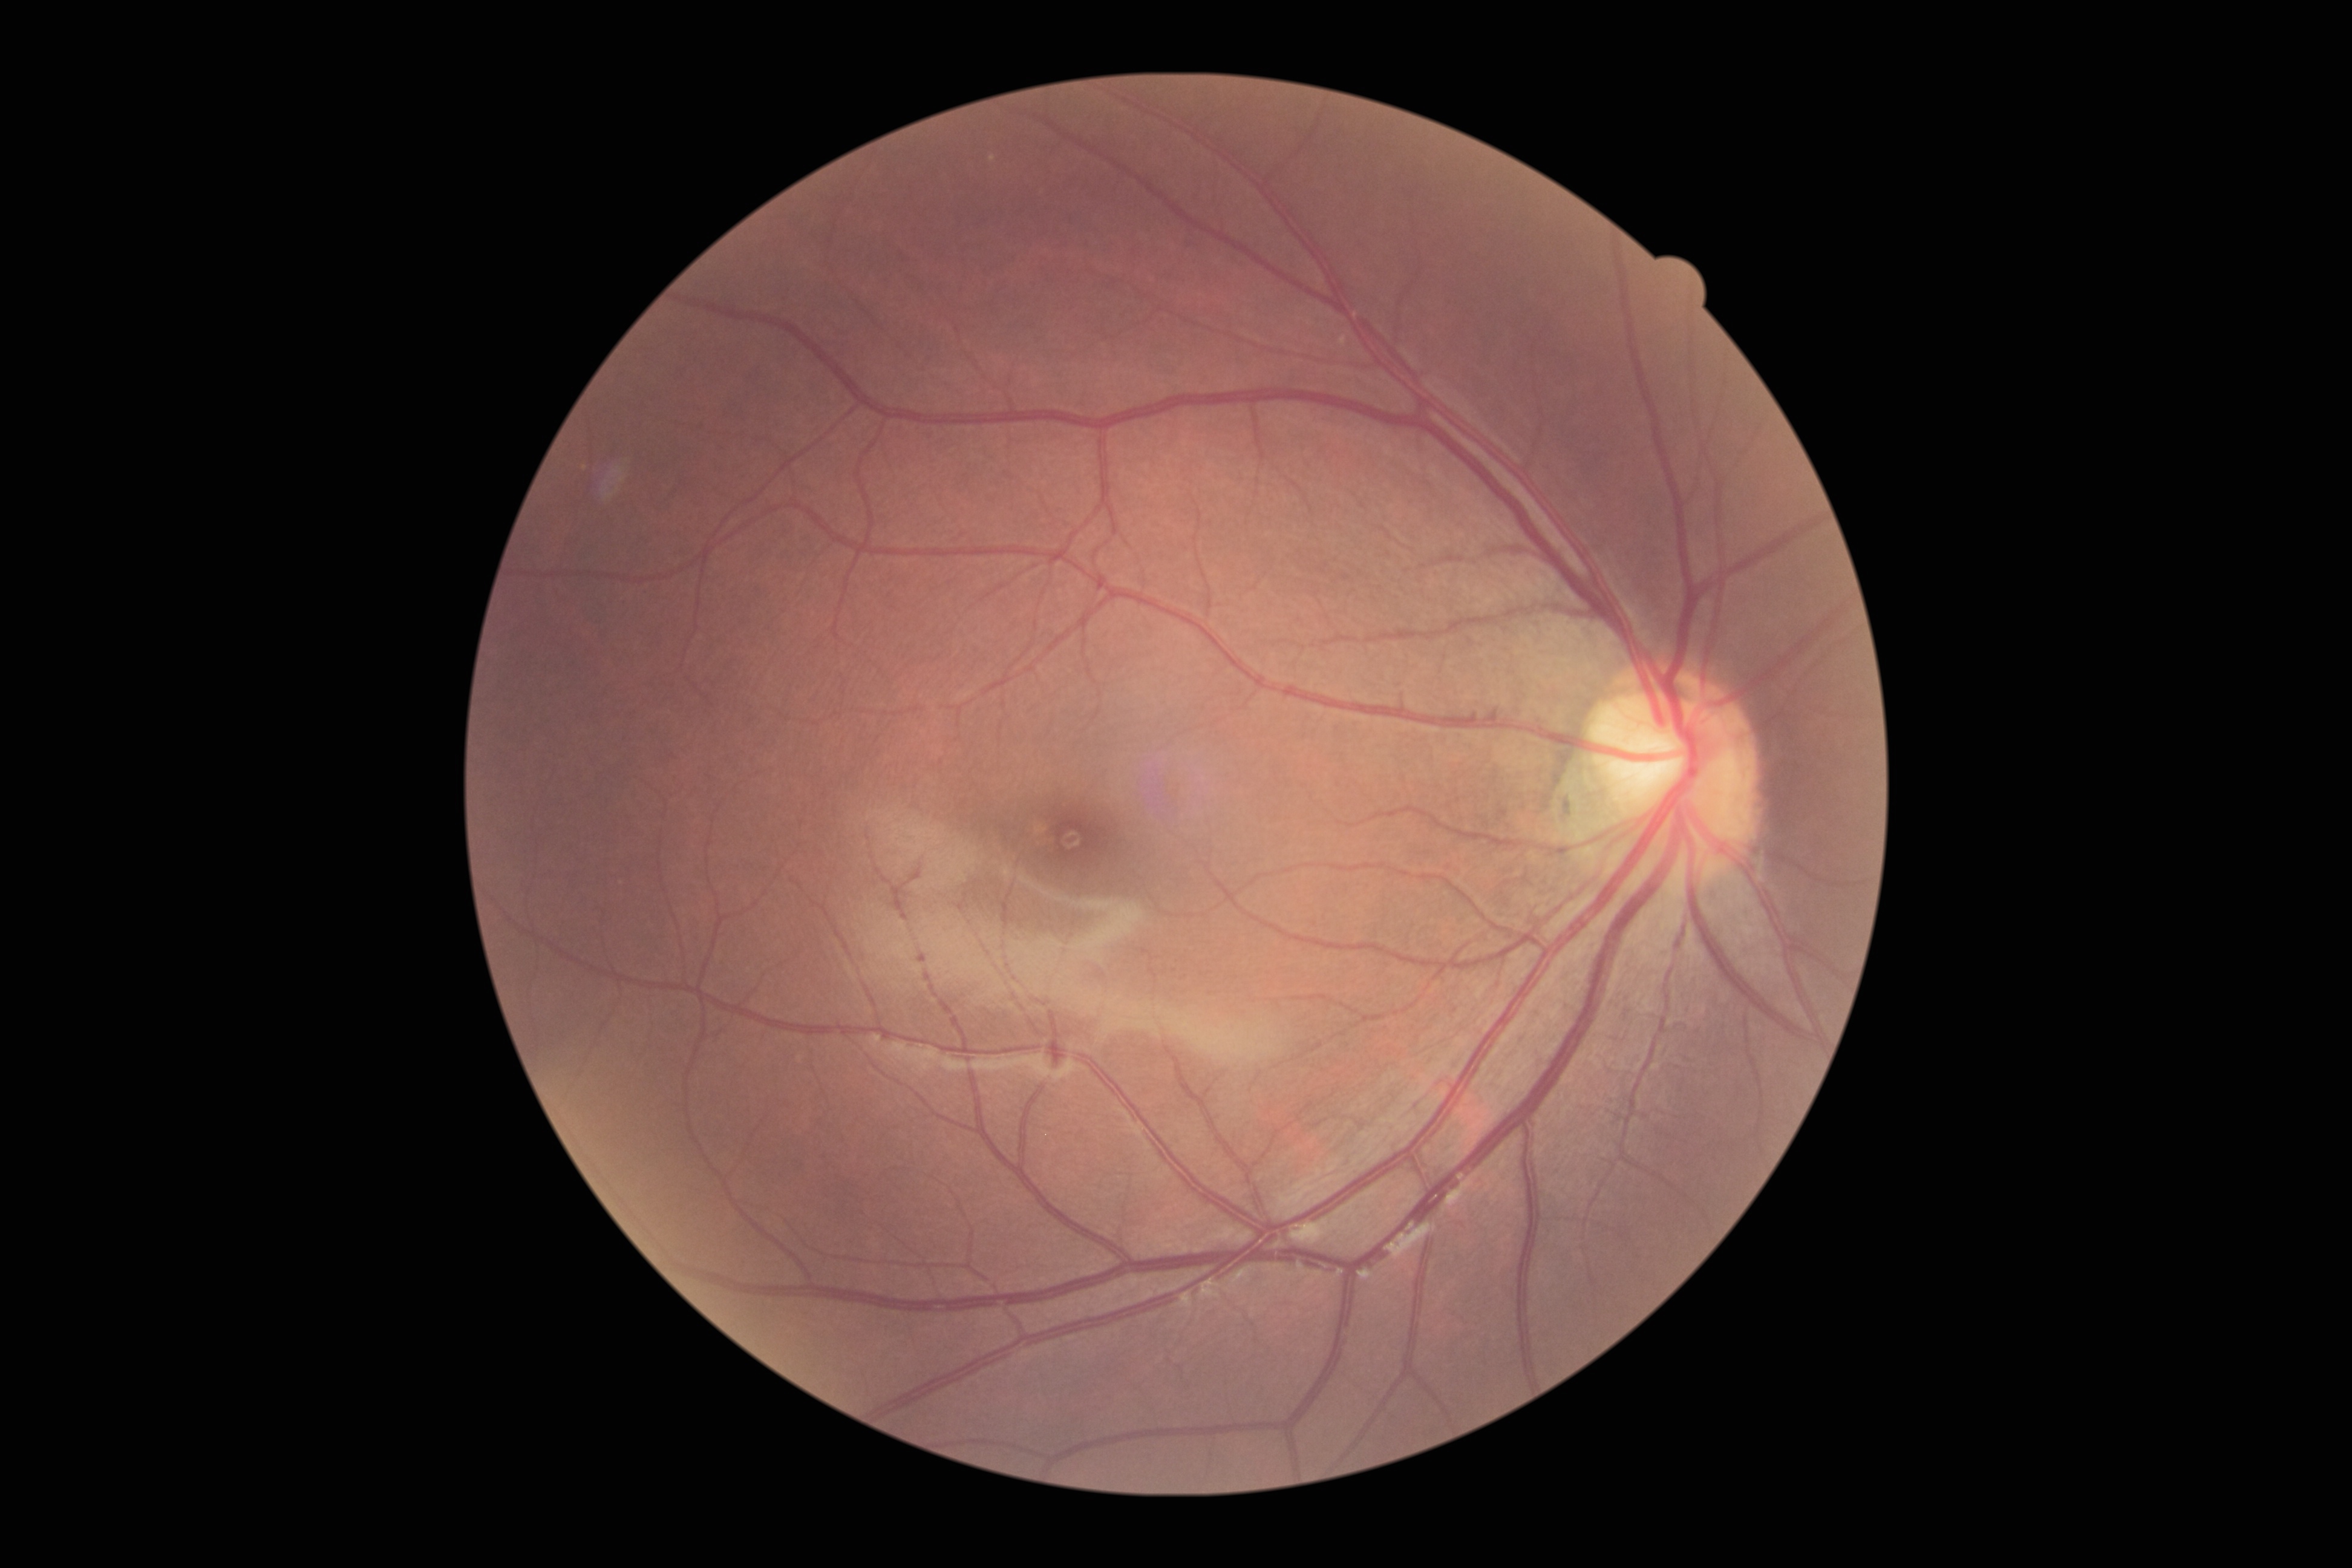

{
  "dr_grade": "no apparent diabetic retinopathy (0)"
}